45° FOV; 2352x1568px
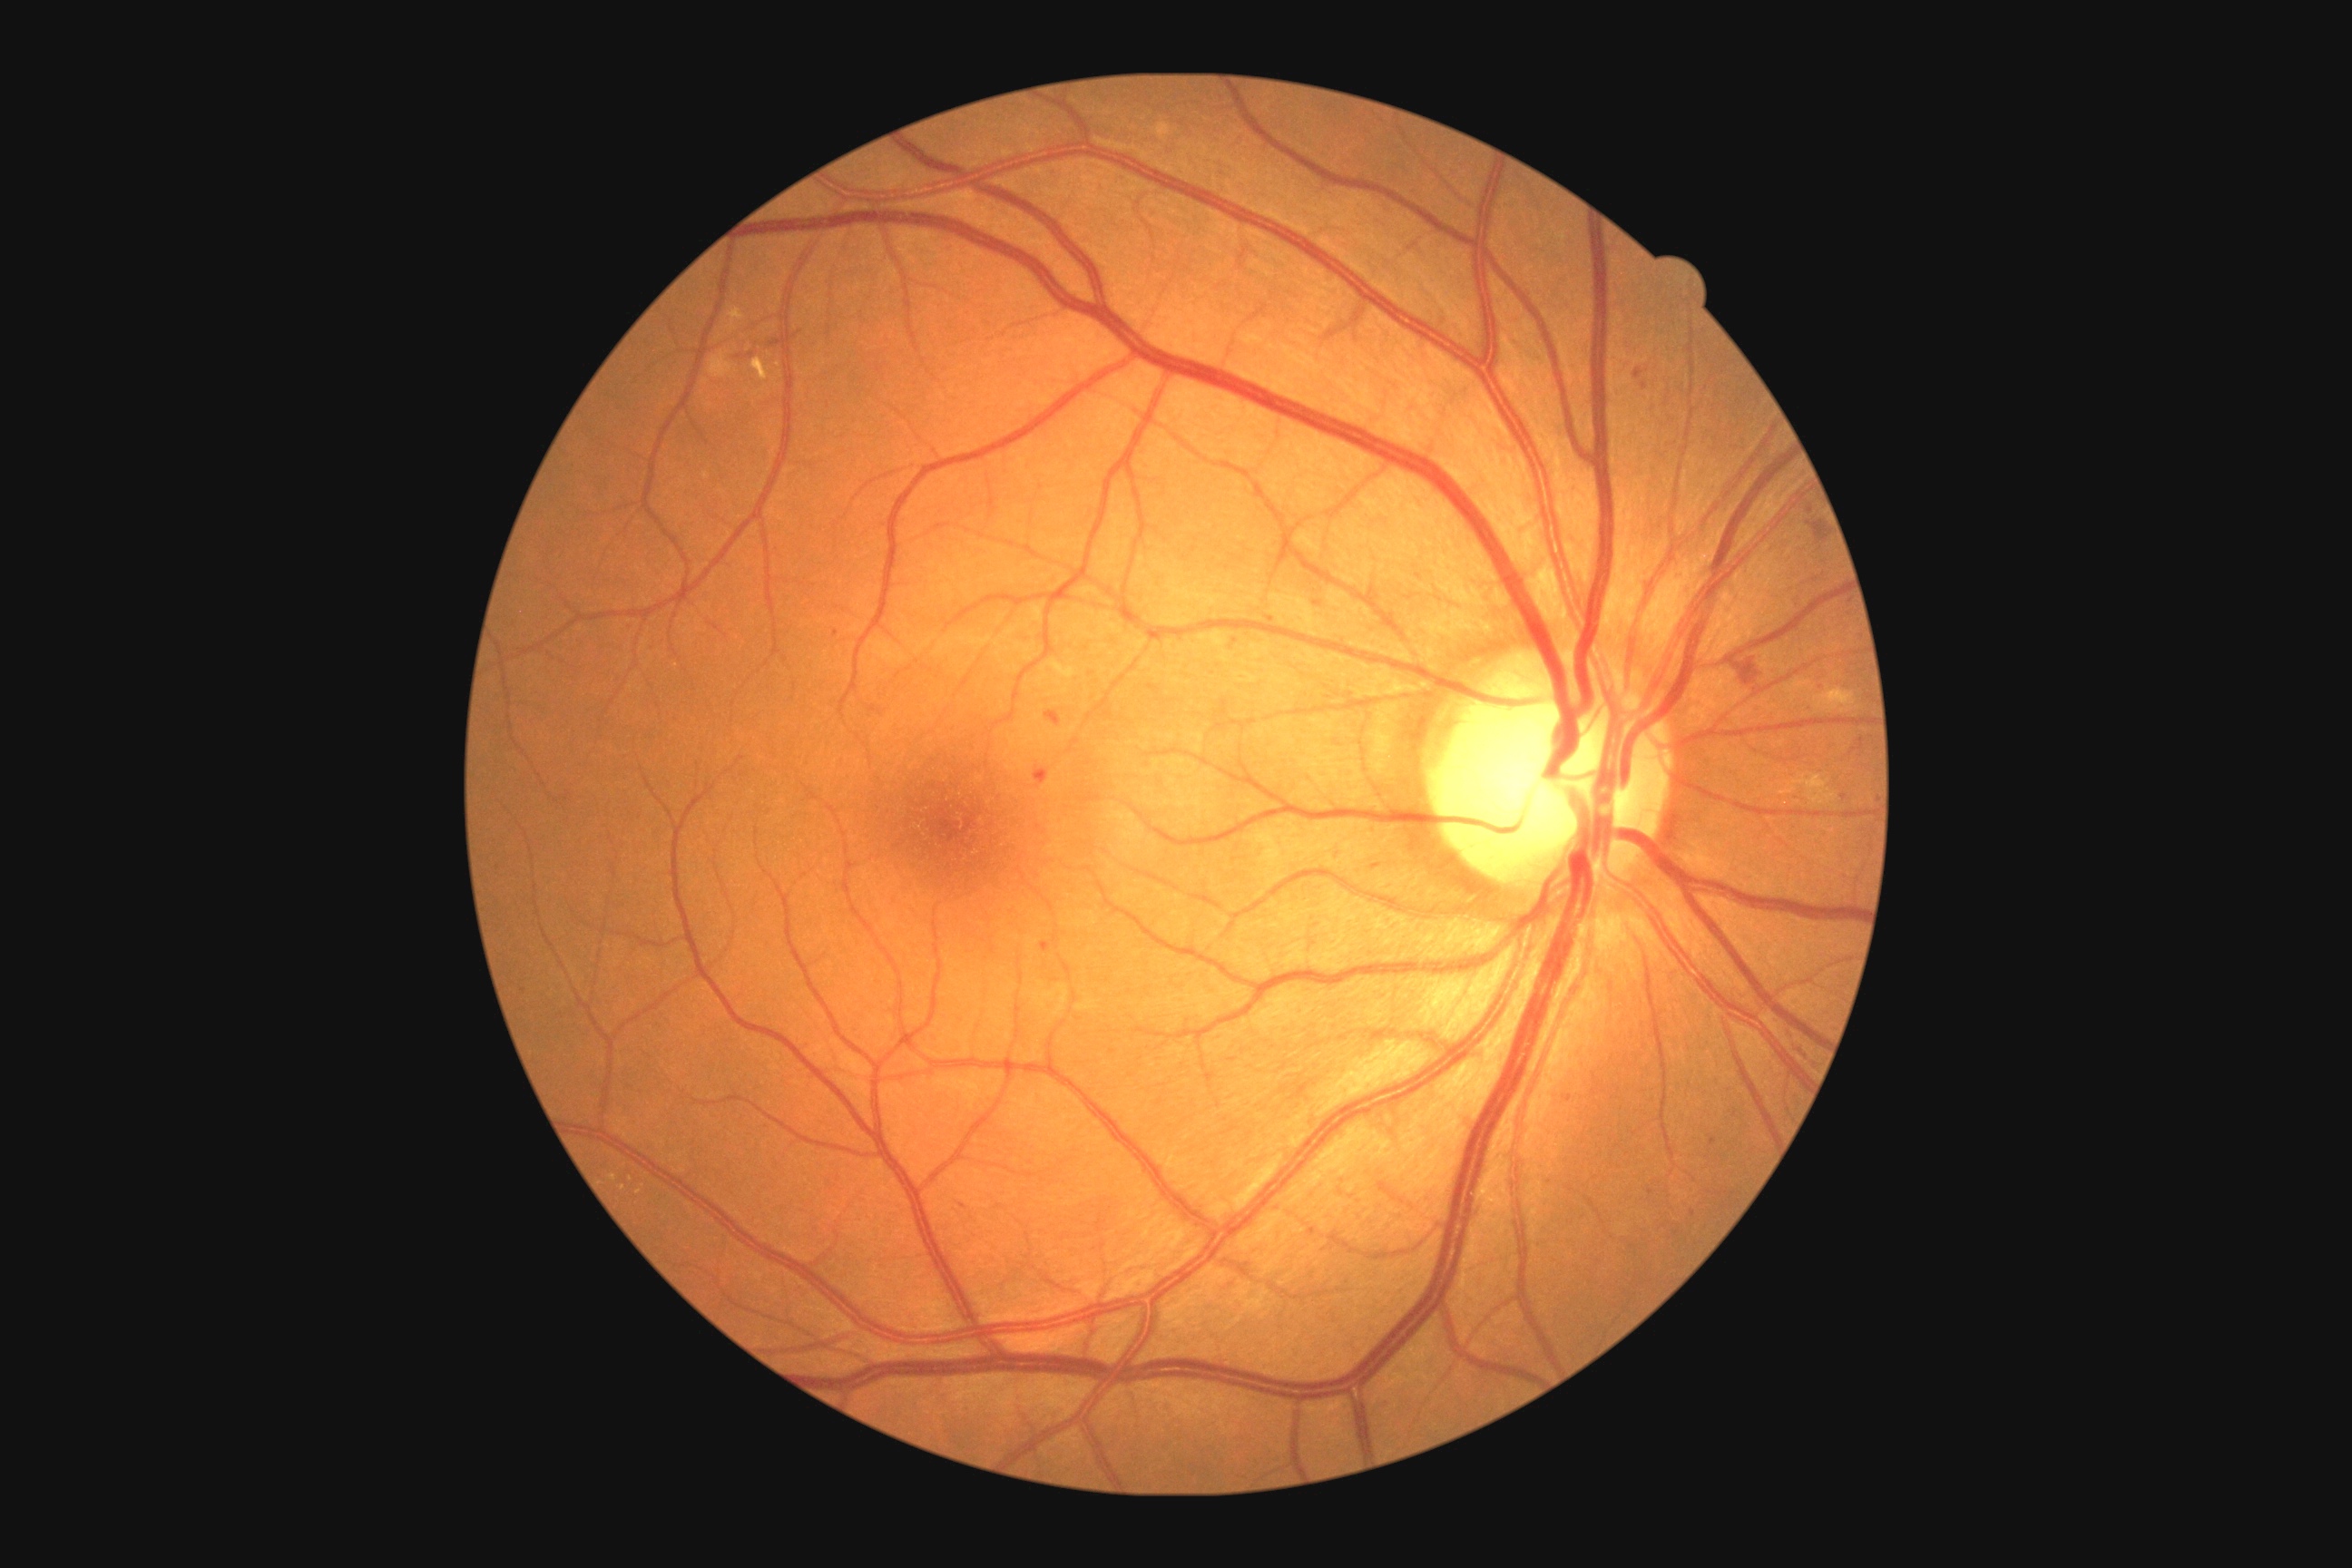 partial: true
dr_grade: 2
dr_grade_name: moderate NPDR
lesions:
  ma:
    - 745, 353, 754, 358
    - 1041, 943, 1050, 952
  ma_small_centers:
    - x=630 y=628
    - x=1271 y=619
    - x=1645 y=386
    - x=1651 y=1192
    - x=1821 y=689
    - x=1693 y=1213
    - x=1811 y=510
    - x=836 y=634